Color fundus photograph, 45-degree field of view — 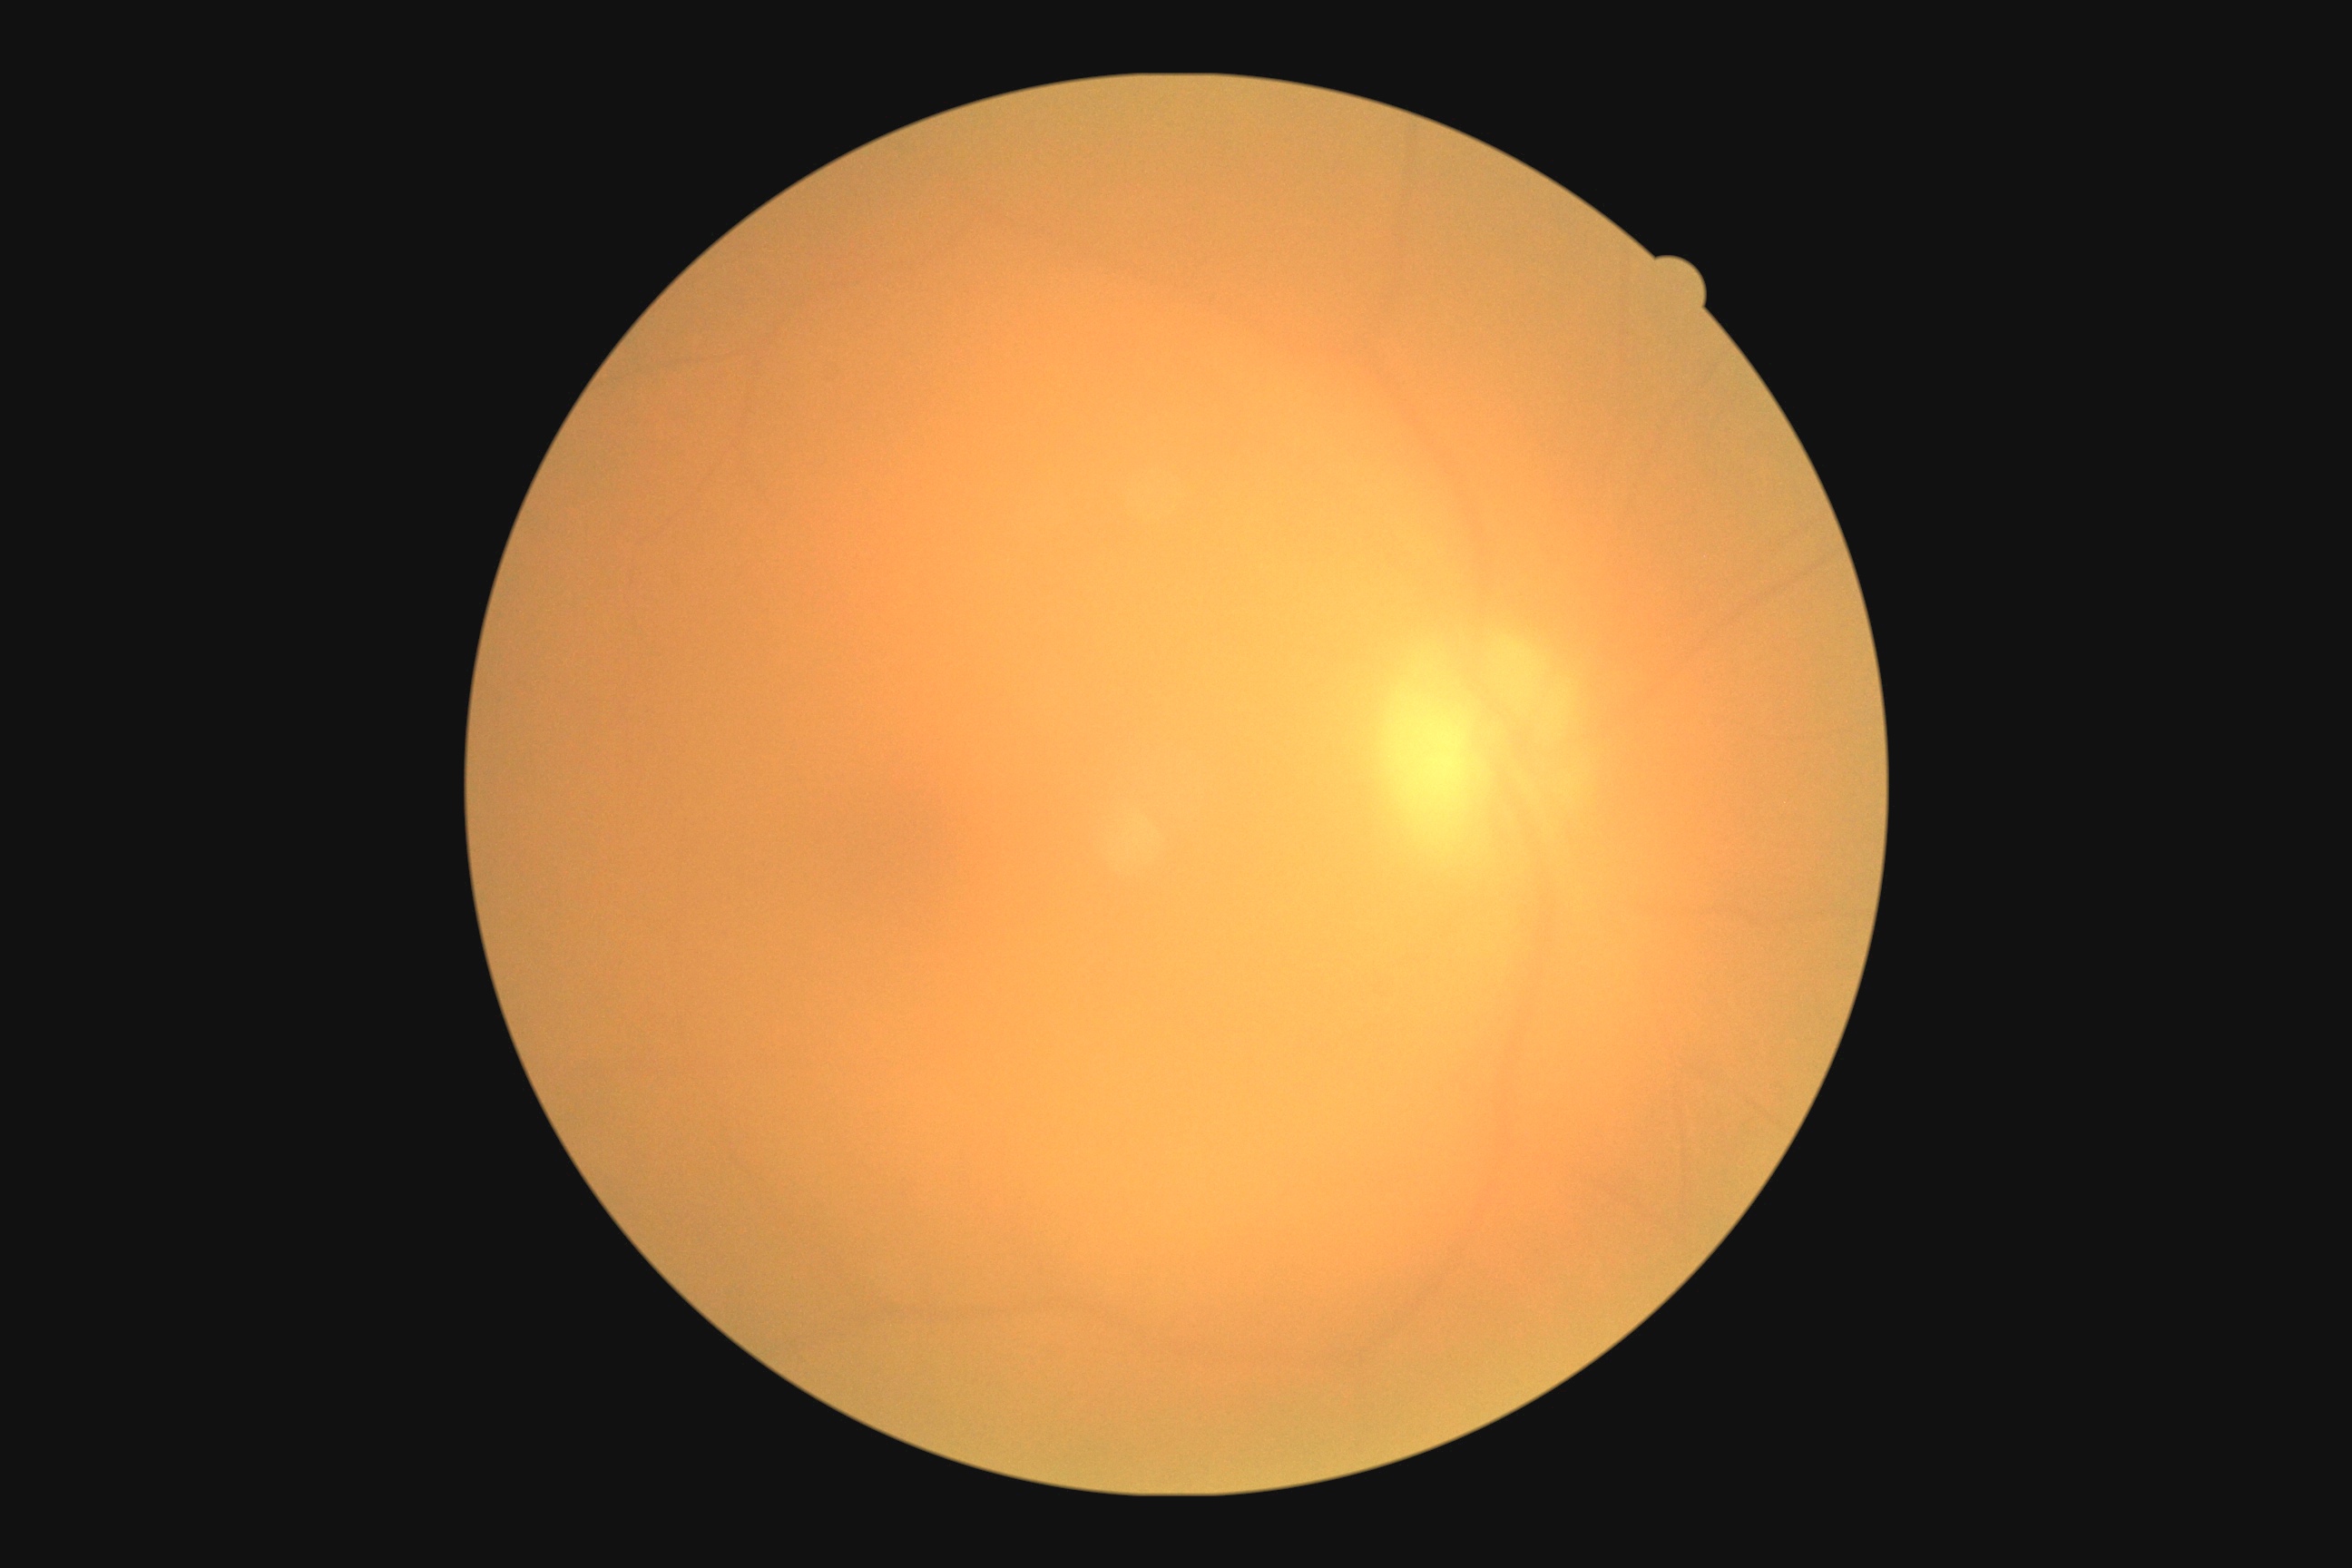
DR severity is 0. No diabetic retinal disease findings.